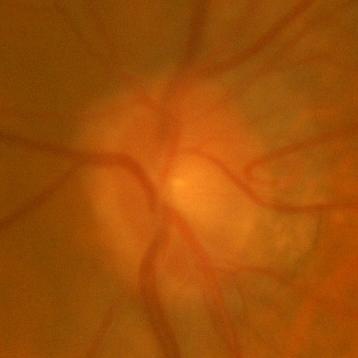 Glaucoma assessment: no signs of glaucoma.